Without pupil dilation · 848x848px · color fundus photograph · FOV: 45 degrees · acquired with a NIDEK AFC-230:
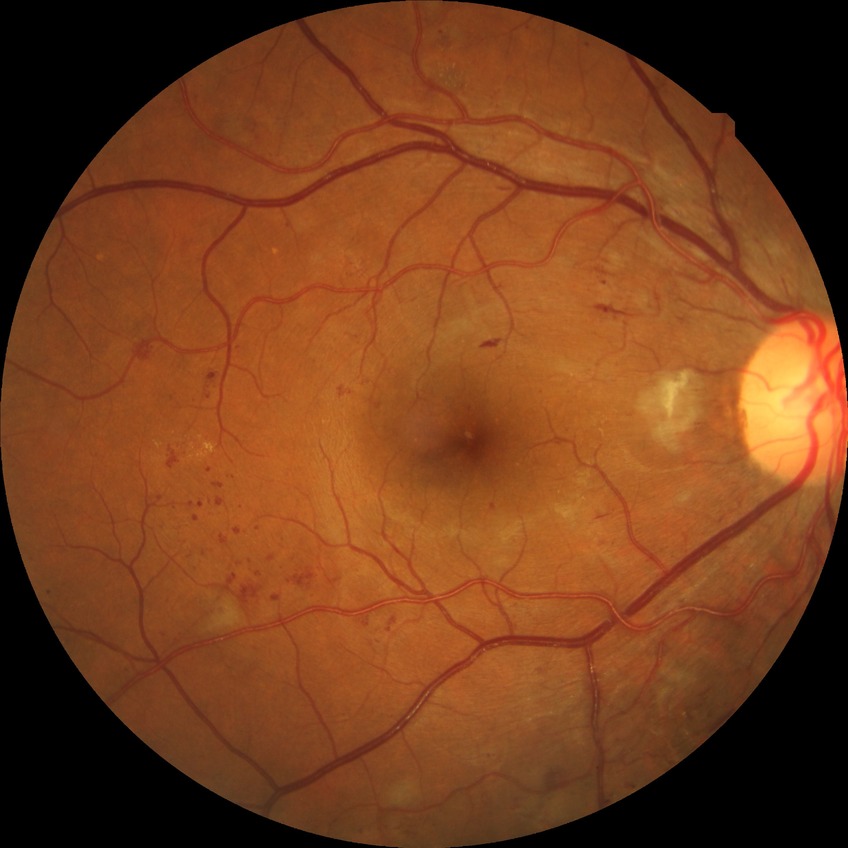
DR grade: PPDR.